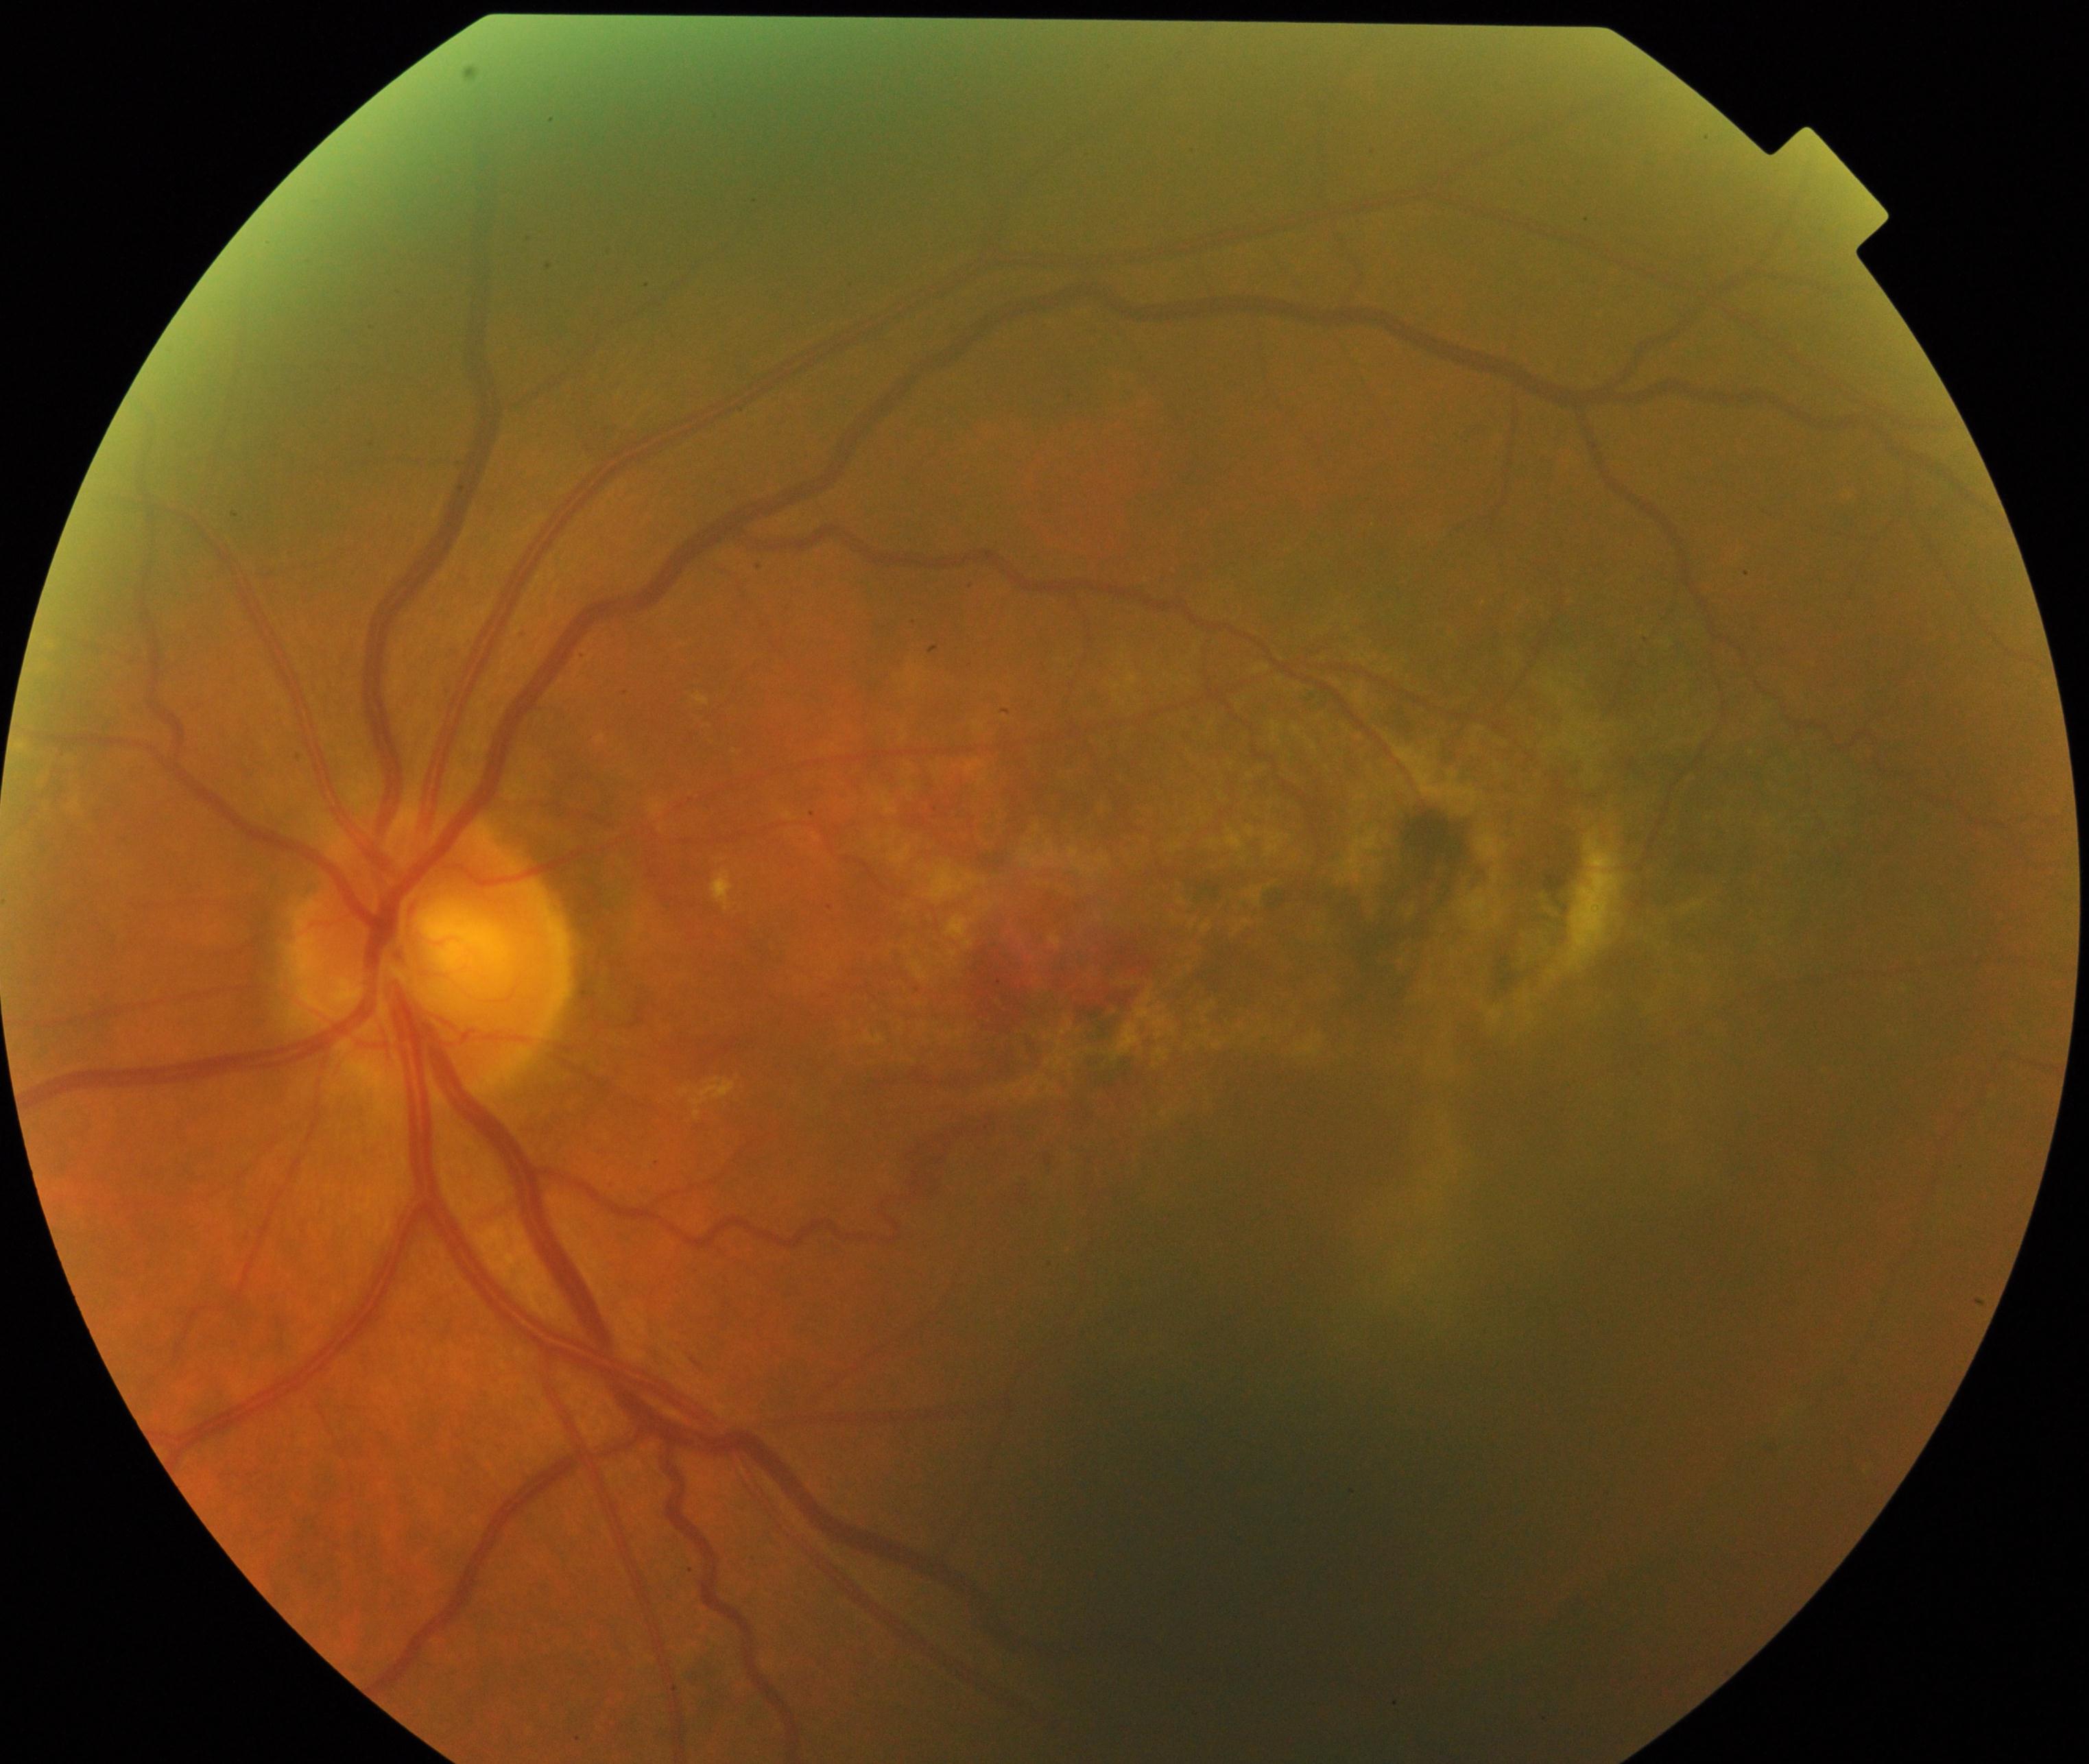 Classification: maculopathy.